Color fundus image, 45-degree field of view — 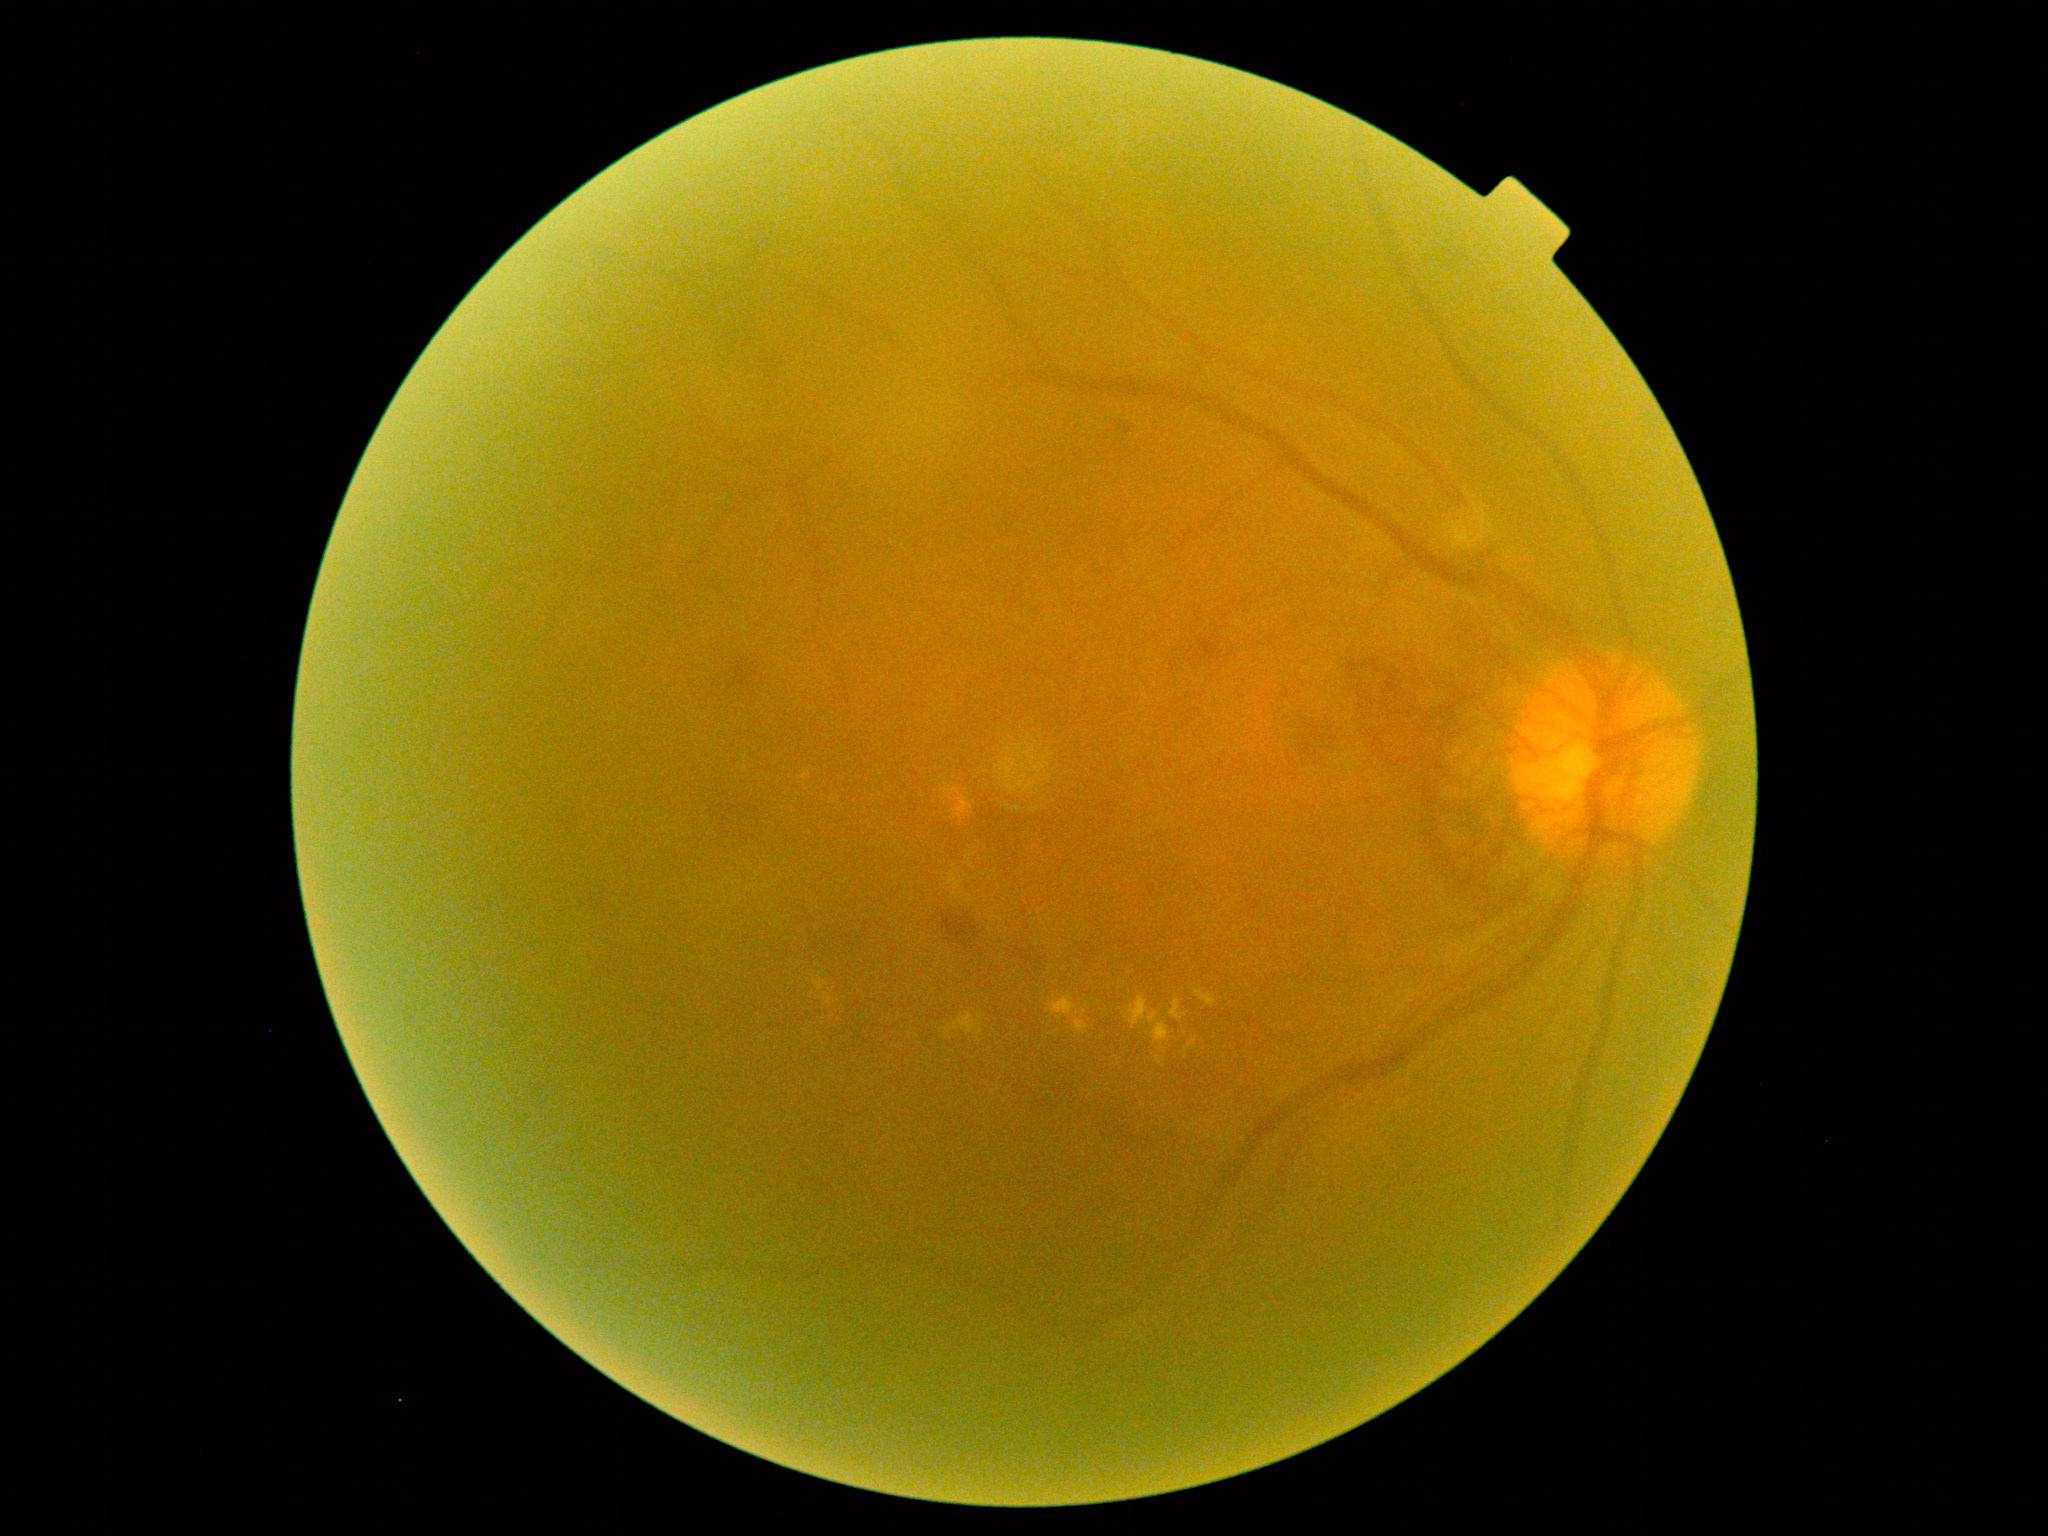 The retinopathy is classified as proliferative diabetic retinopathy. Retinopathy: 4.